Wide-field fundus photograph of an infant. 130° field of view (Clarity RetCam 3). Image size 640x480:
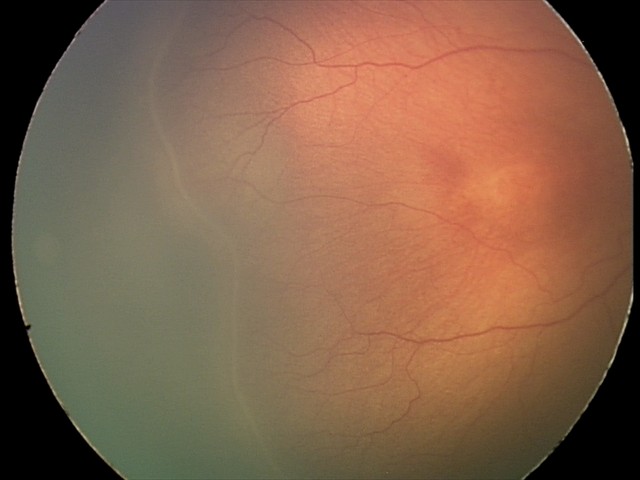
Plus form = absent, retinopathy of prematurity stage = 2 — ridge with height and width at the demarcation line.